FOV: 45 degrees
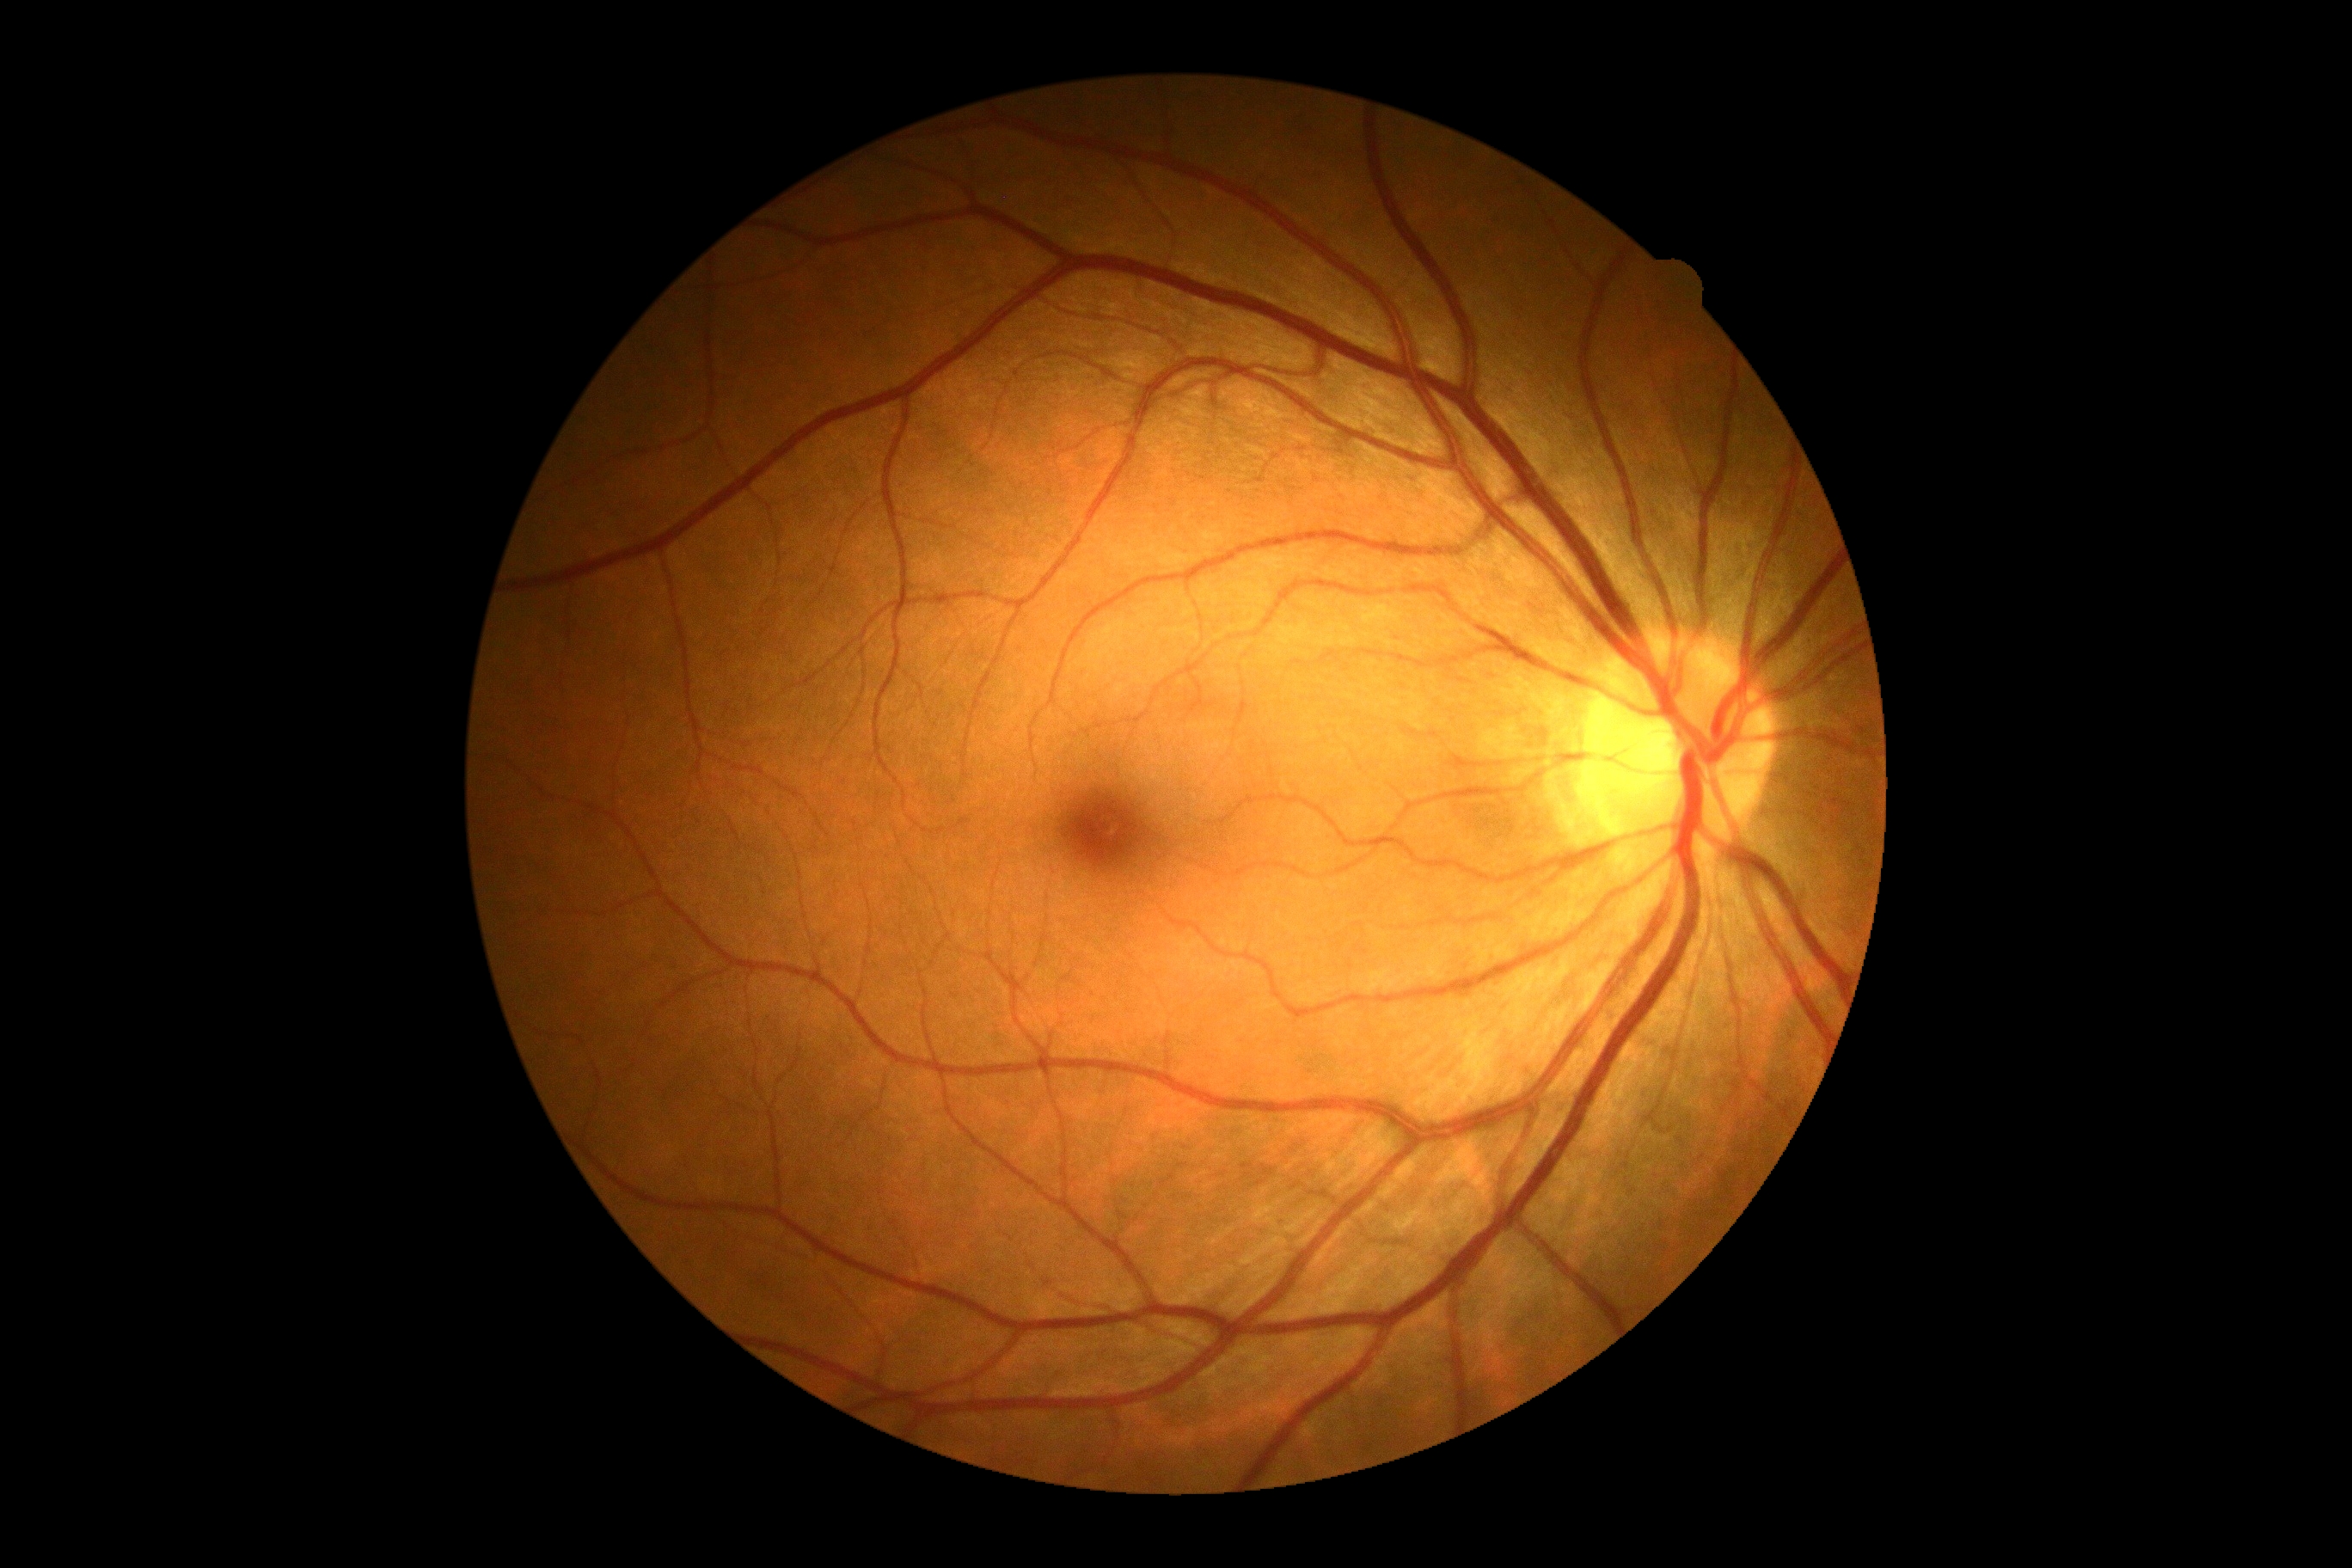

DR is no apparent retinopathy (grade 0).